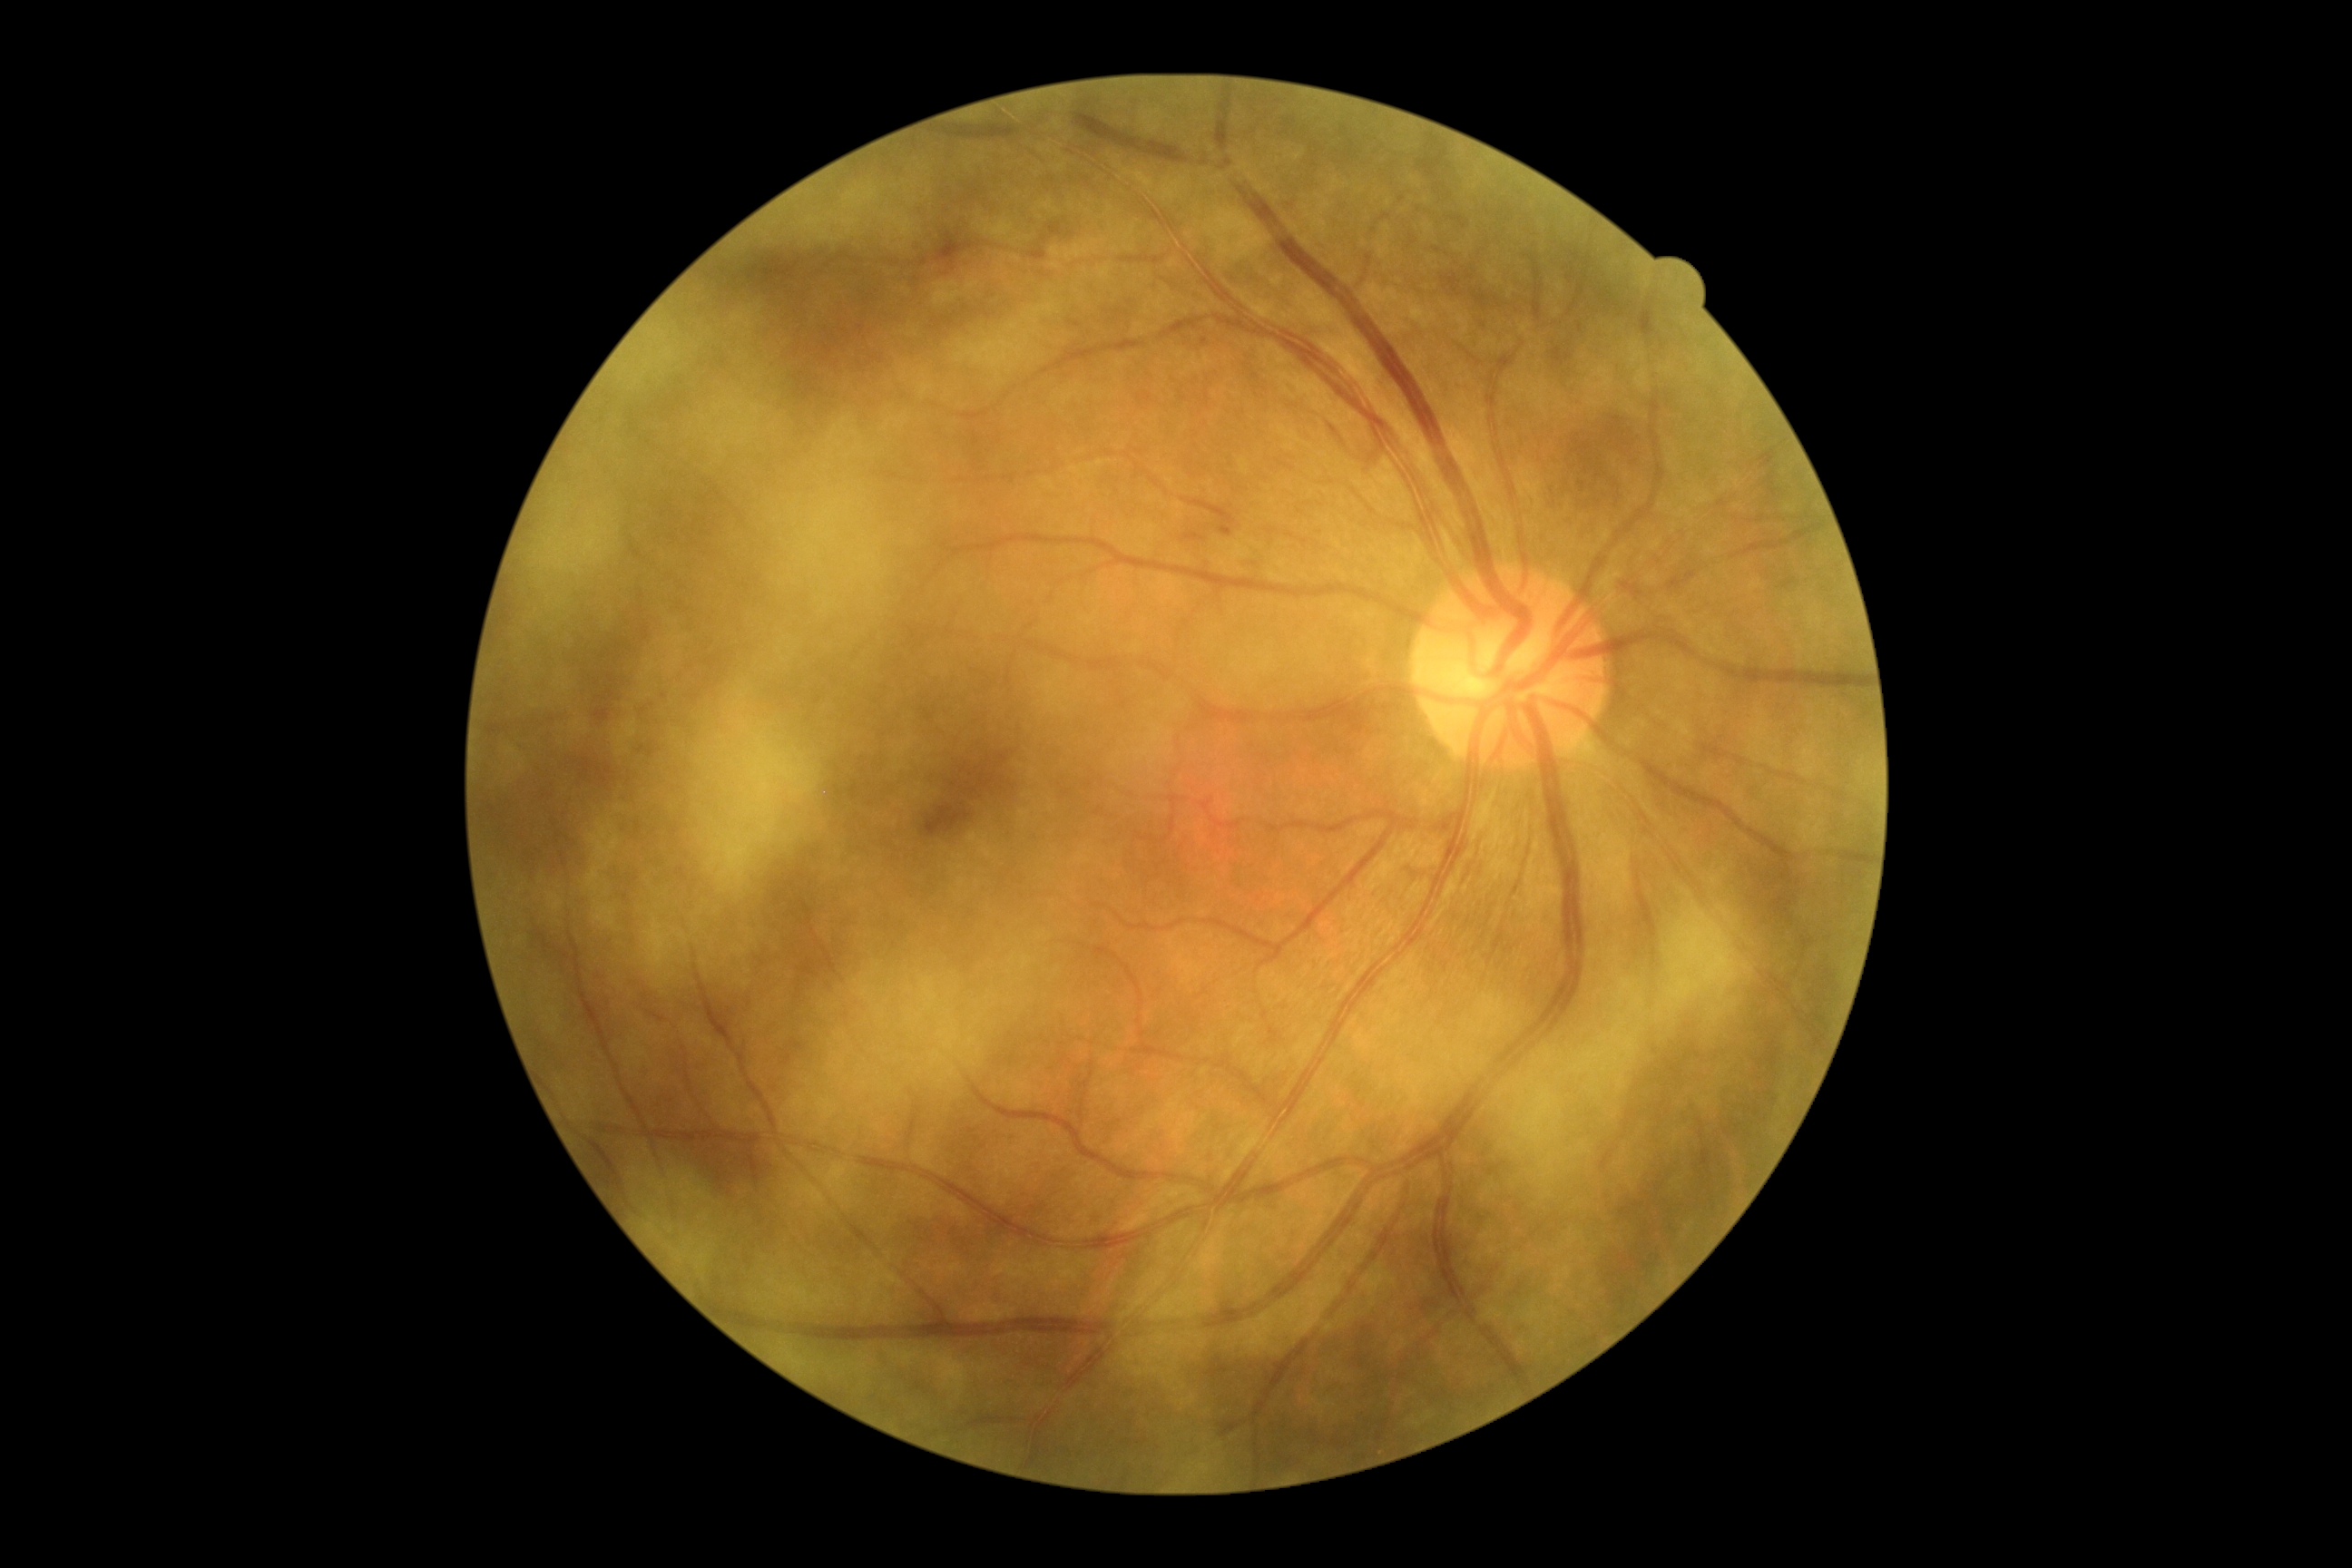 DR: grade 1 (mild NPDR).